848x848px · without pupil dilation · diabetic retinopathy graded by the modified Davis classification
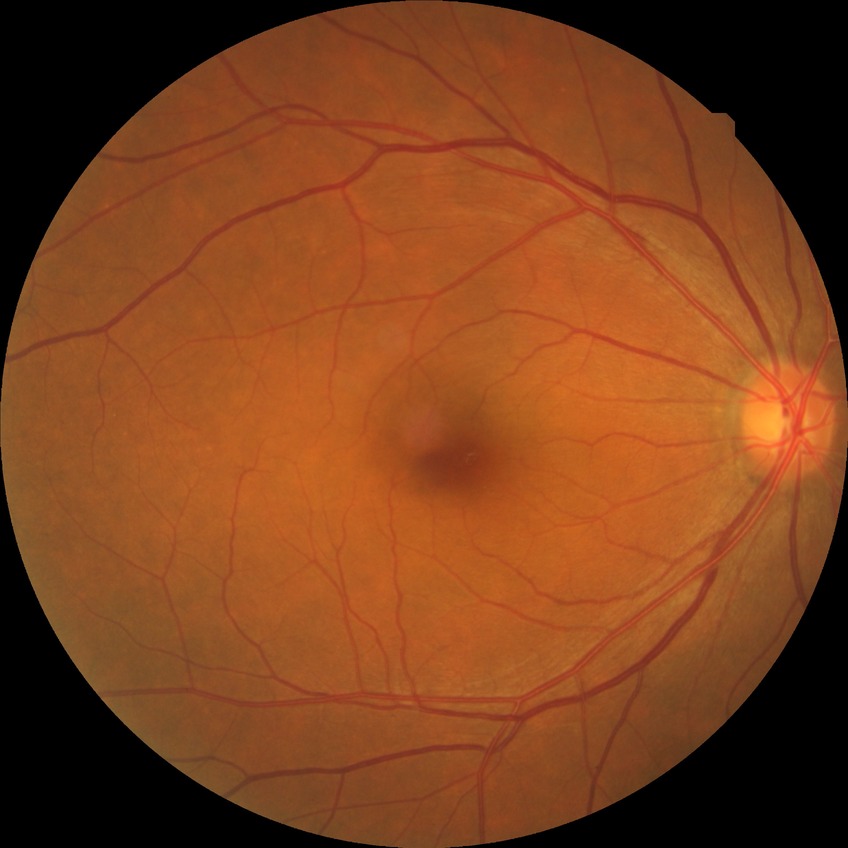

Findings:
* diabetic retinopathy (DR) — no diabetic retinopathy (NDR)